Posterior pole photograph: 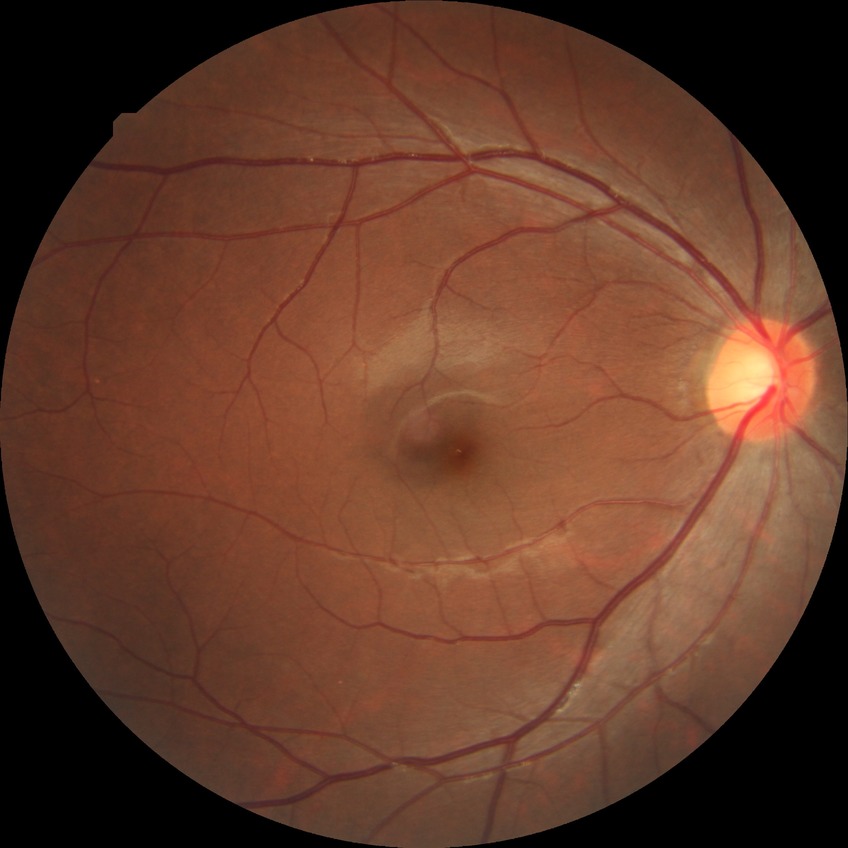
Diabetic retinopathy (DR) is NDR (no diabetic retinopathy).